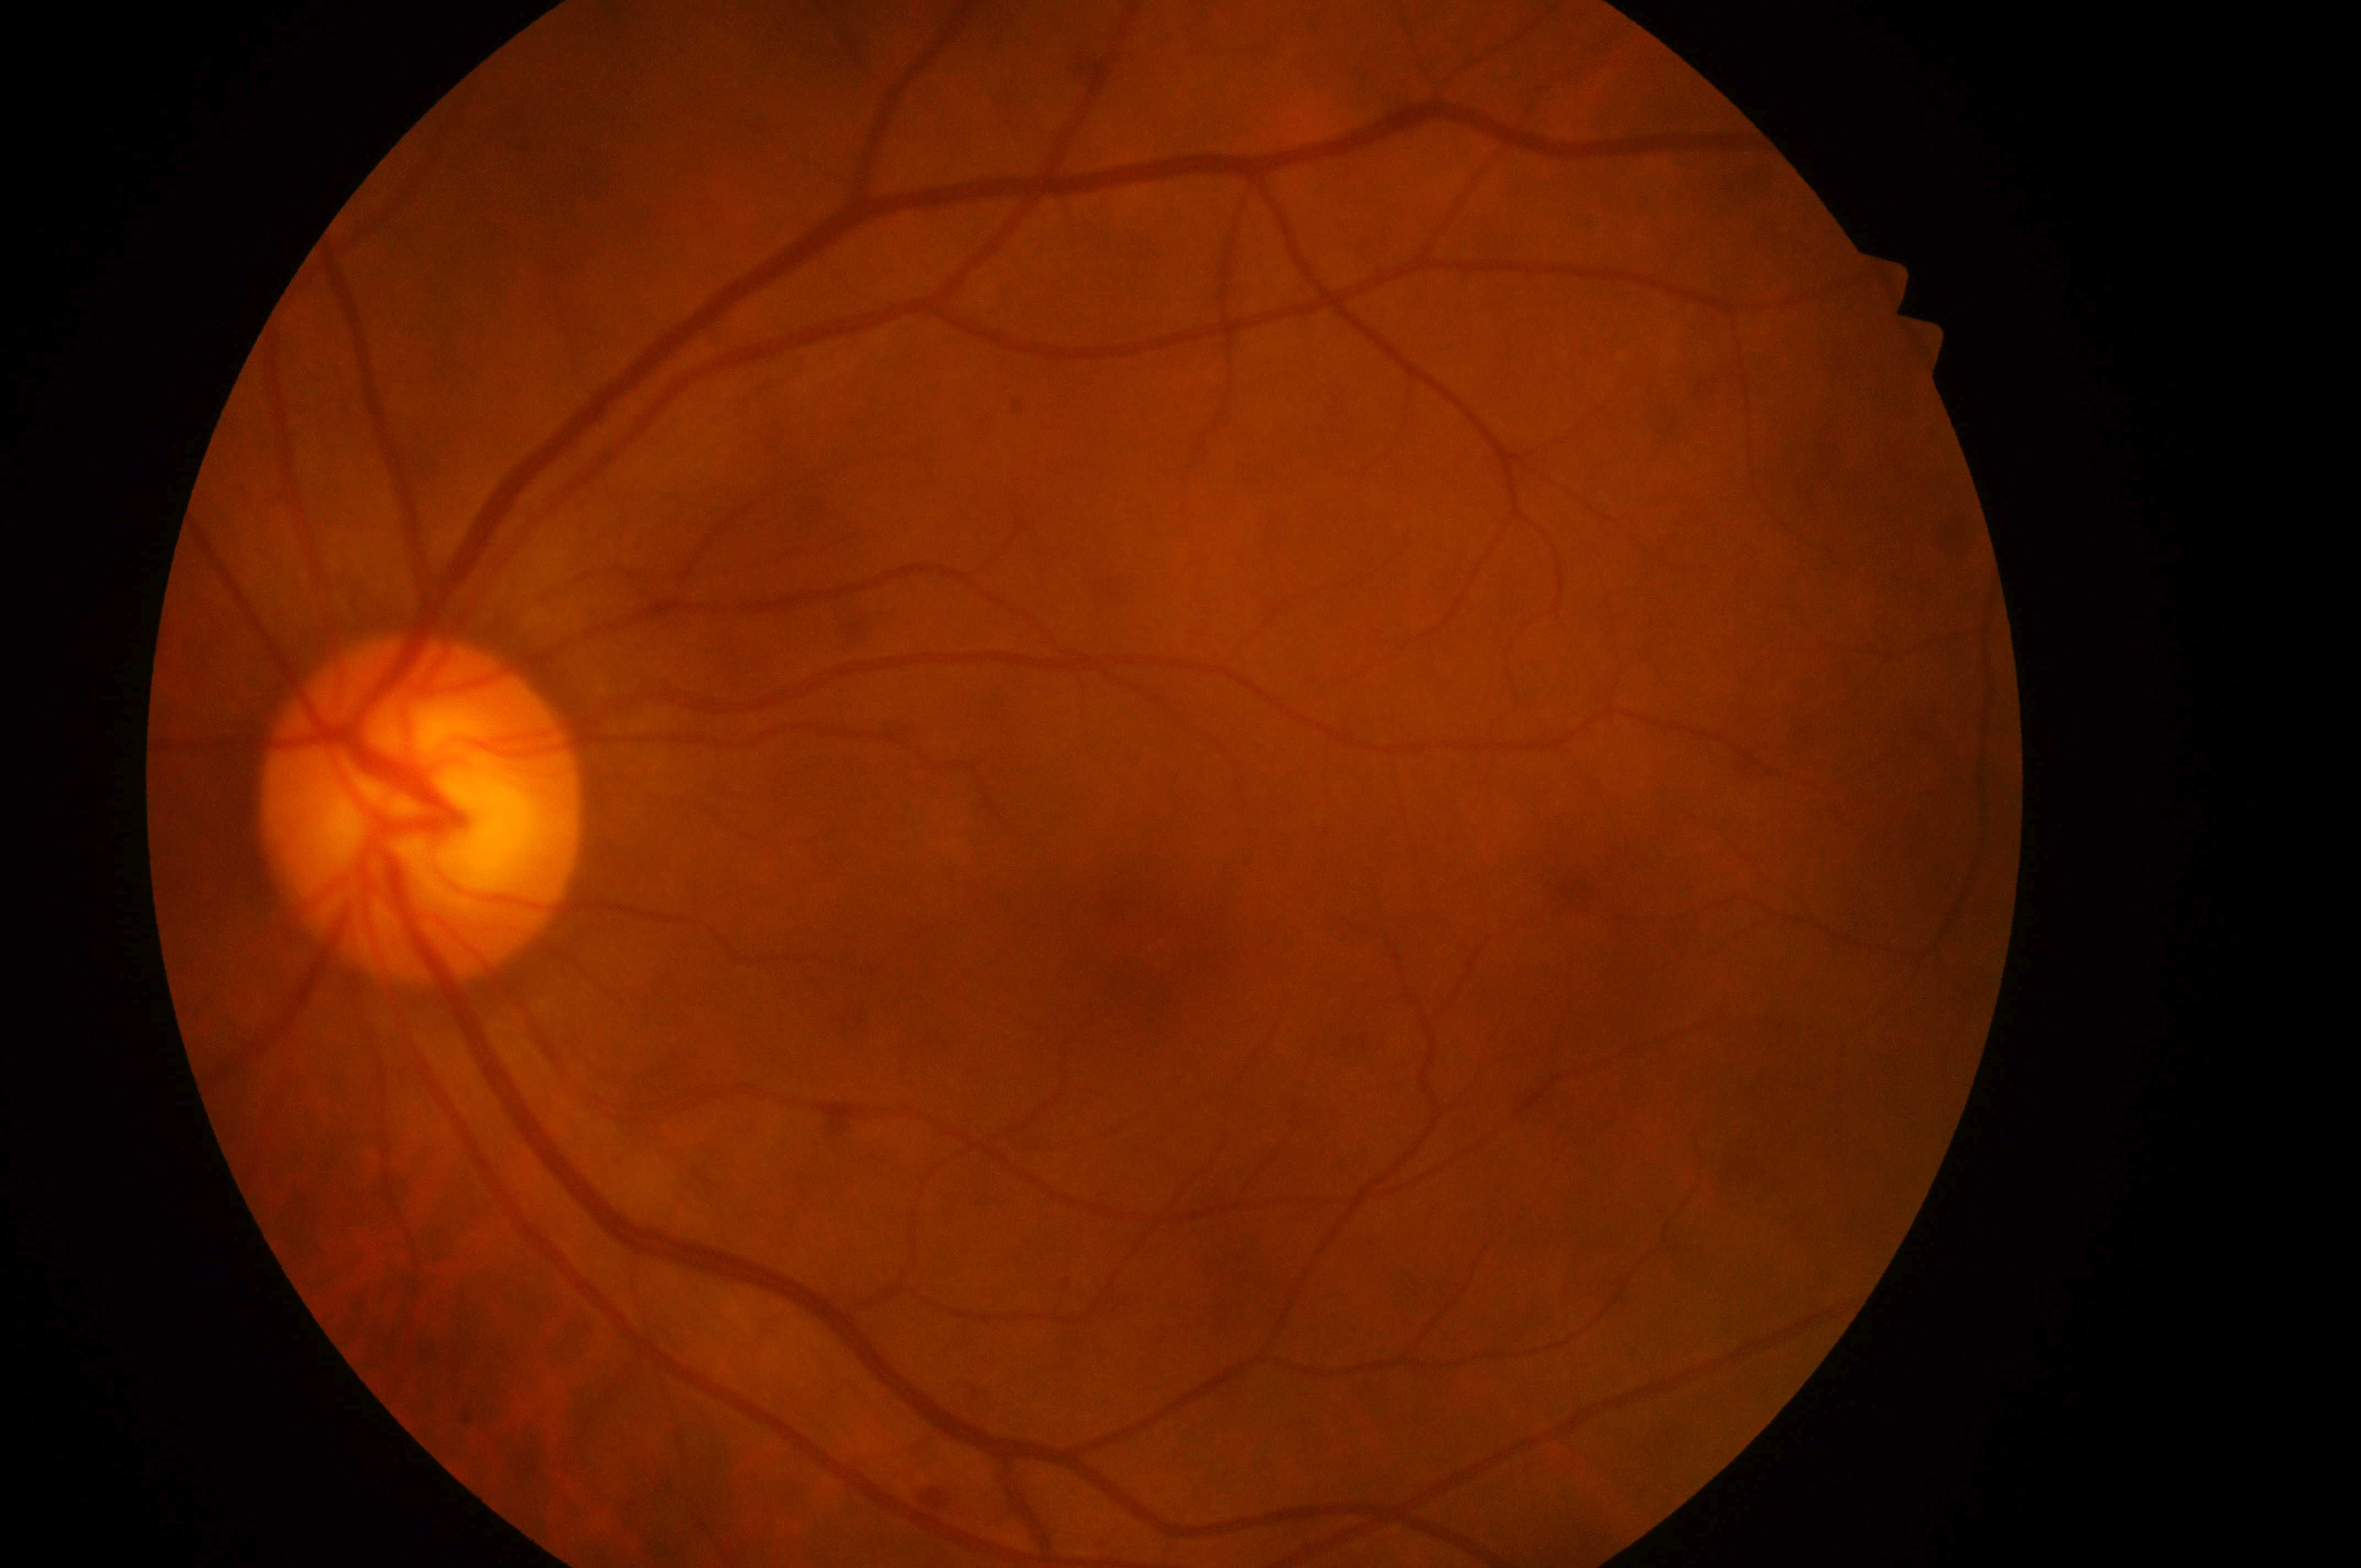
Diabetic macular edema (DME): 0. Diabetic retinopathy (DR): grade 0. Imaged eye: left. Fovea located at (1157, 956). No diabetic retinopathy; no macular edema risk. Optic disk: (410, 820).